Image size 2352x1568.
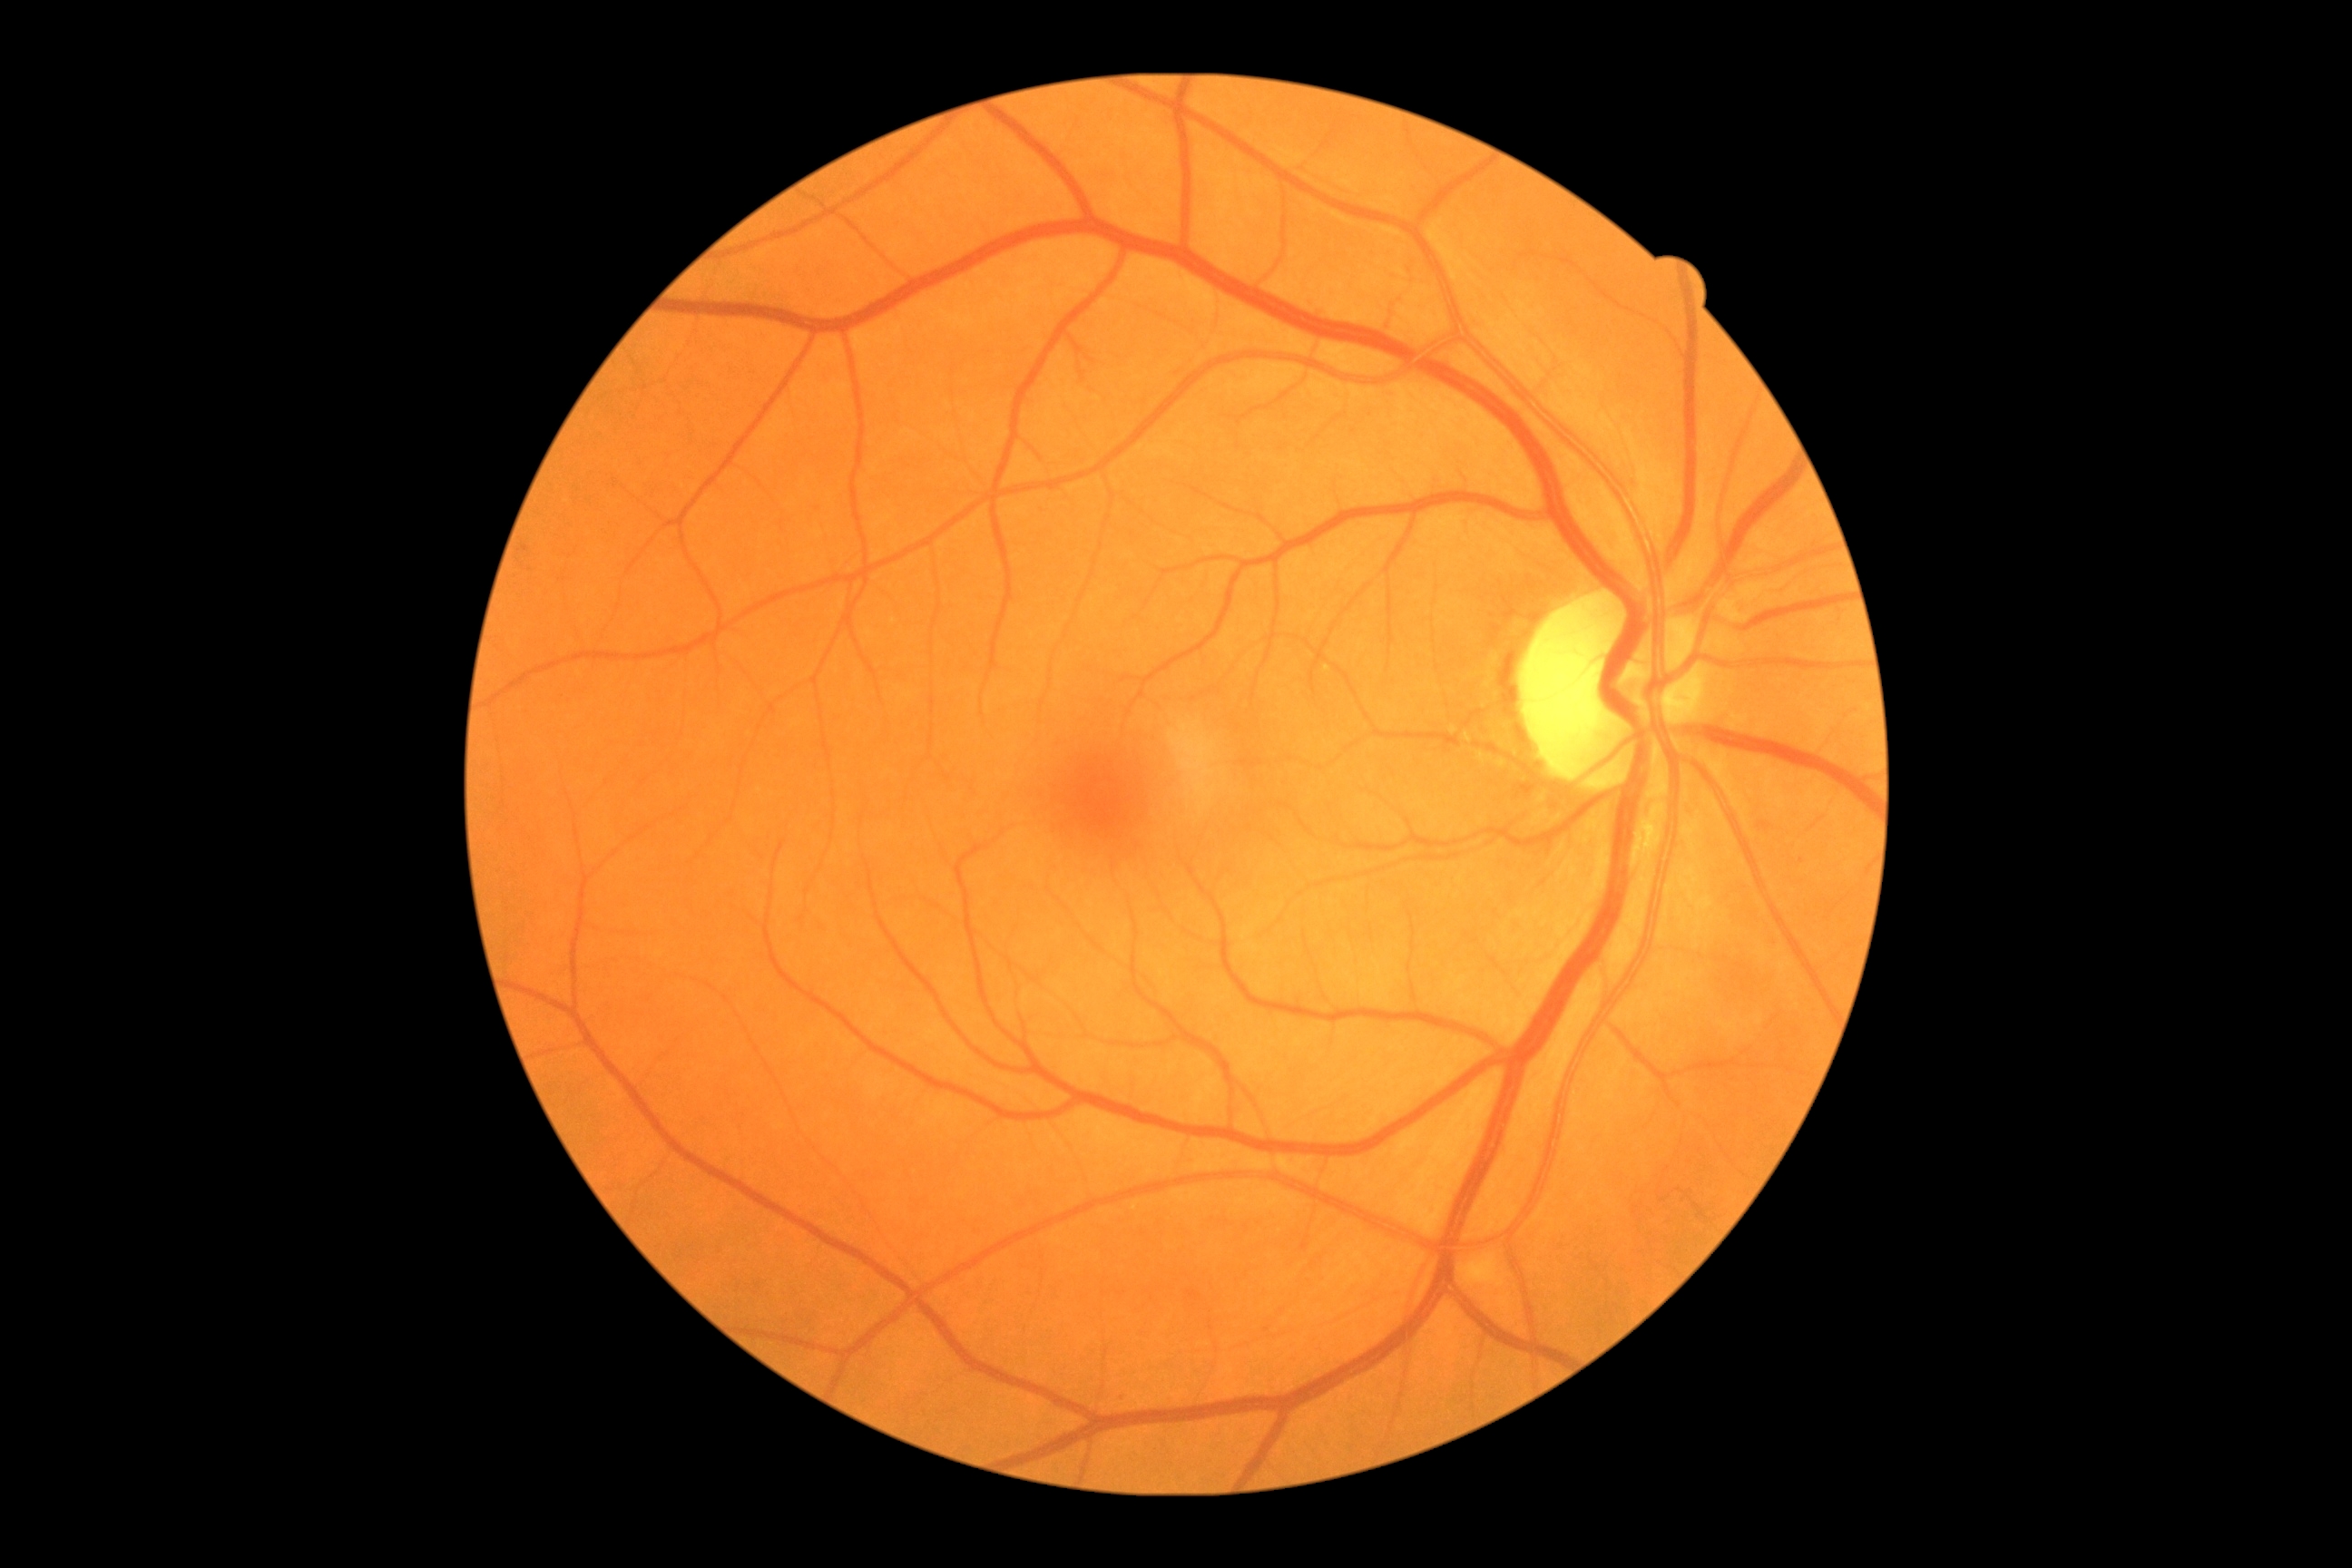
Diabetic retinopathy severity: 0/4.